Color fundus image; 45° FOV; 2048x1536px: 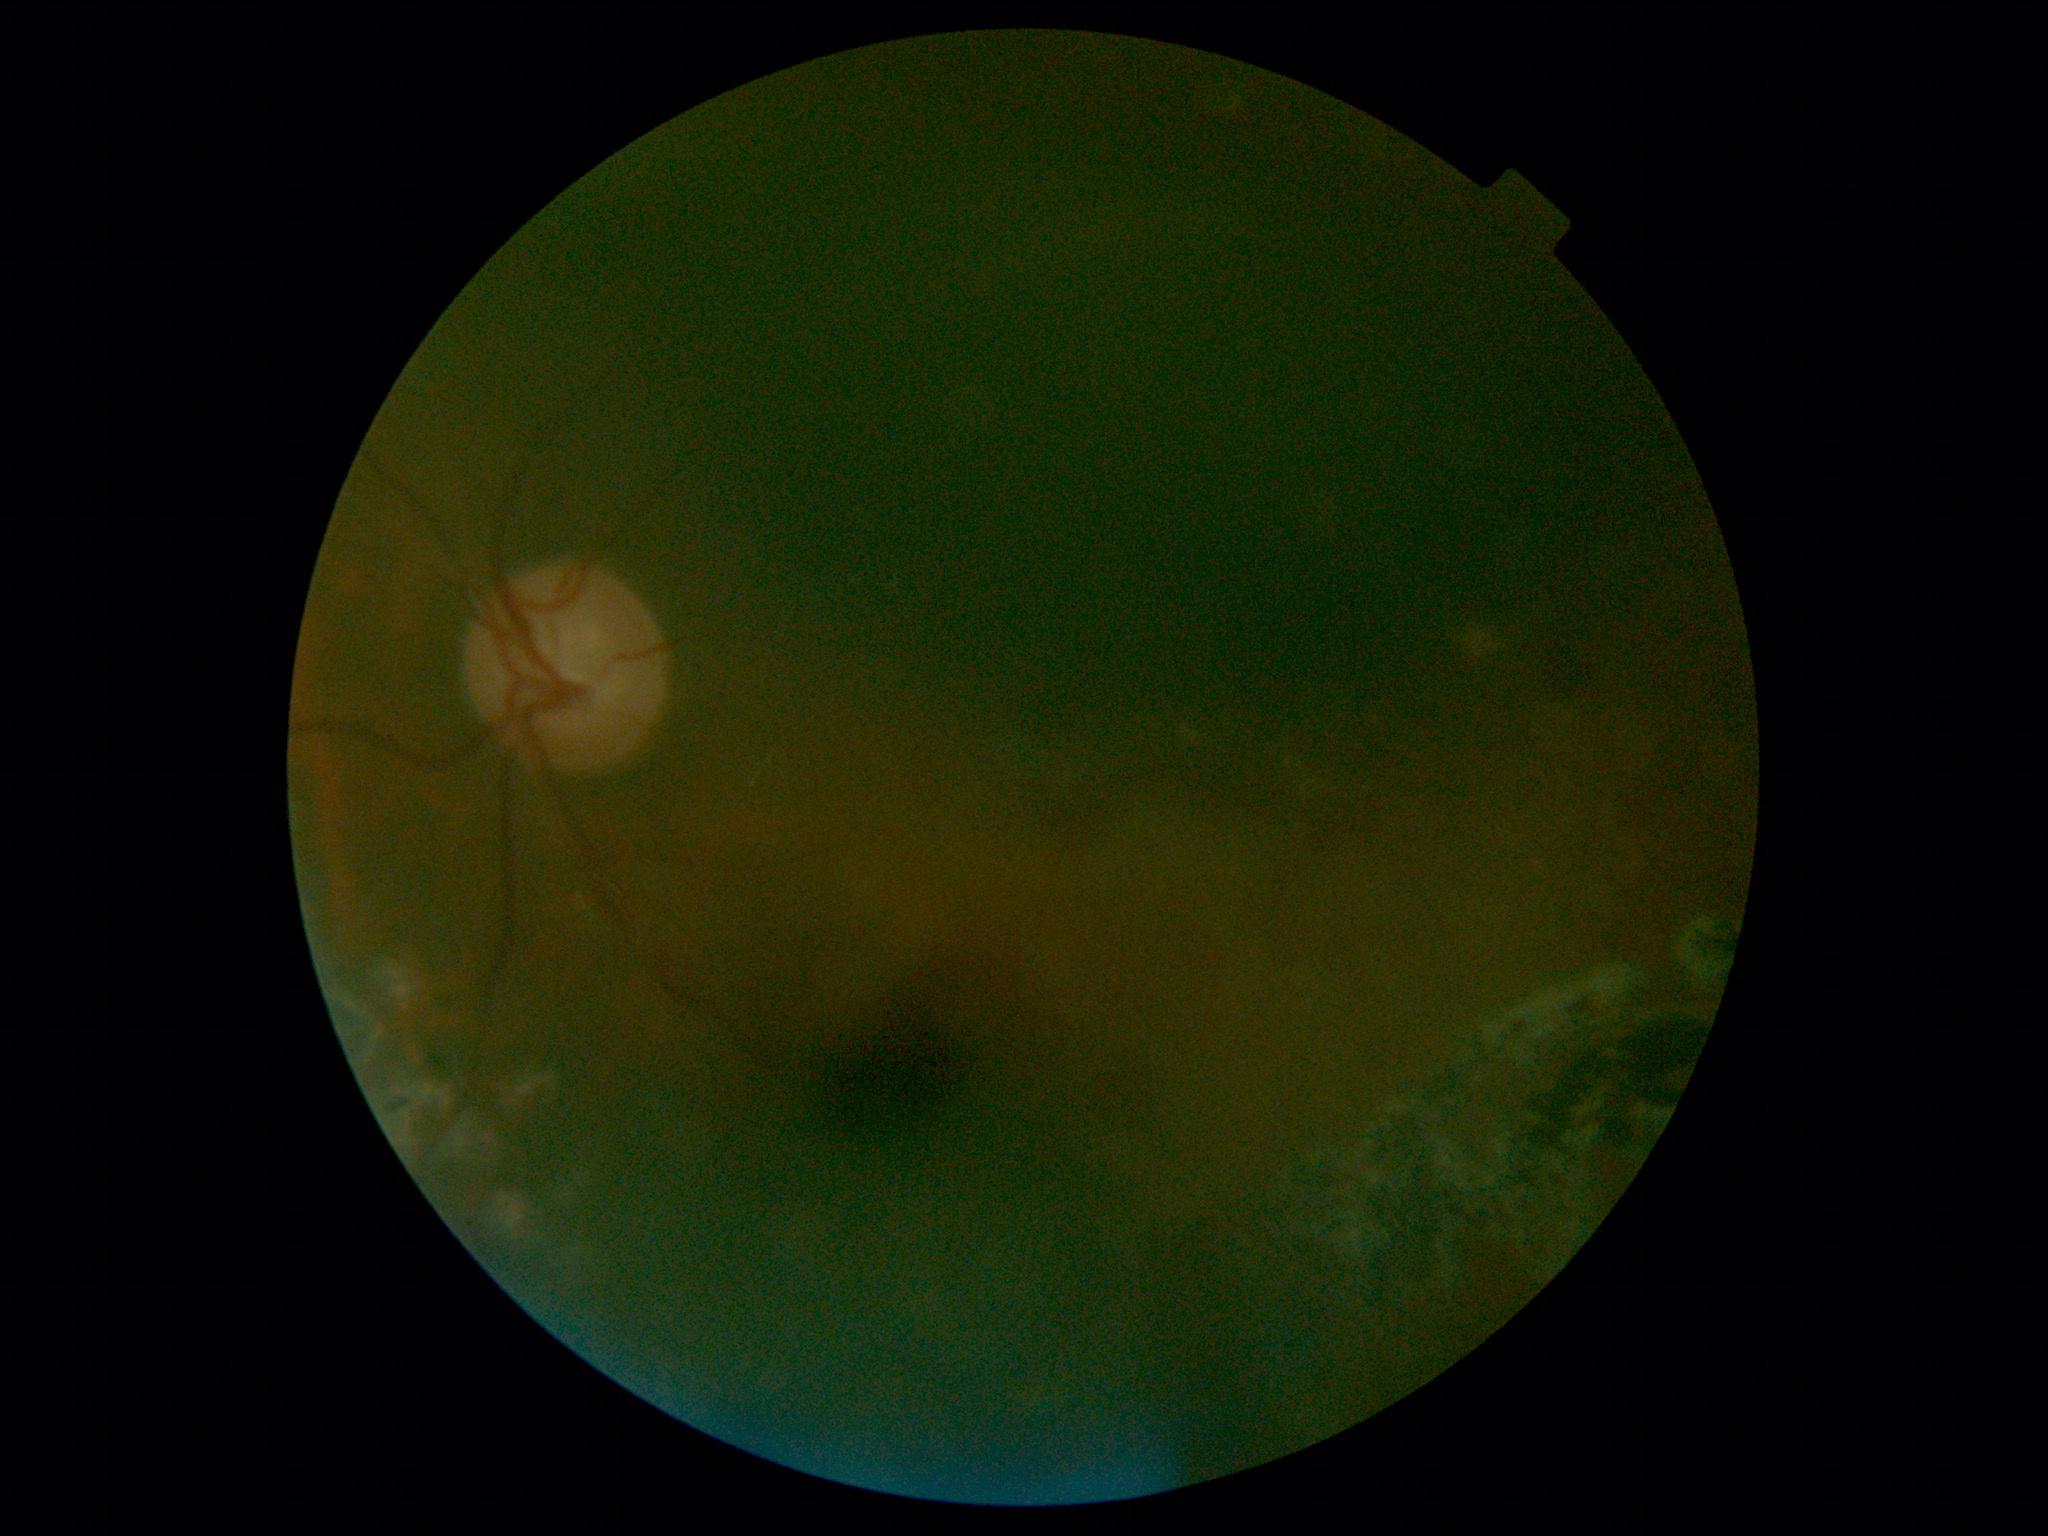 Diabetic retinopathy (DR): ungradable.
Quality too poor to assess for DR.